Wide-field contact fundus photograph of an infant.
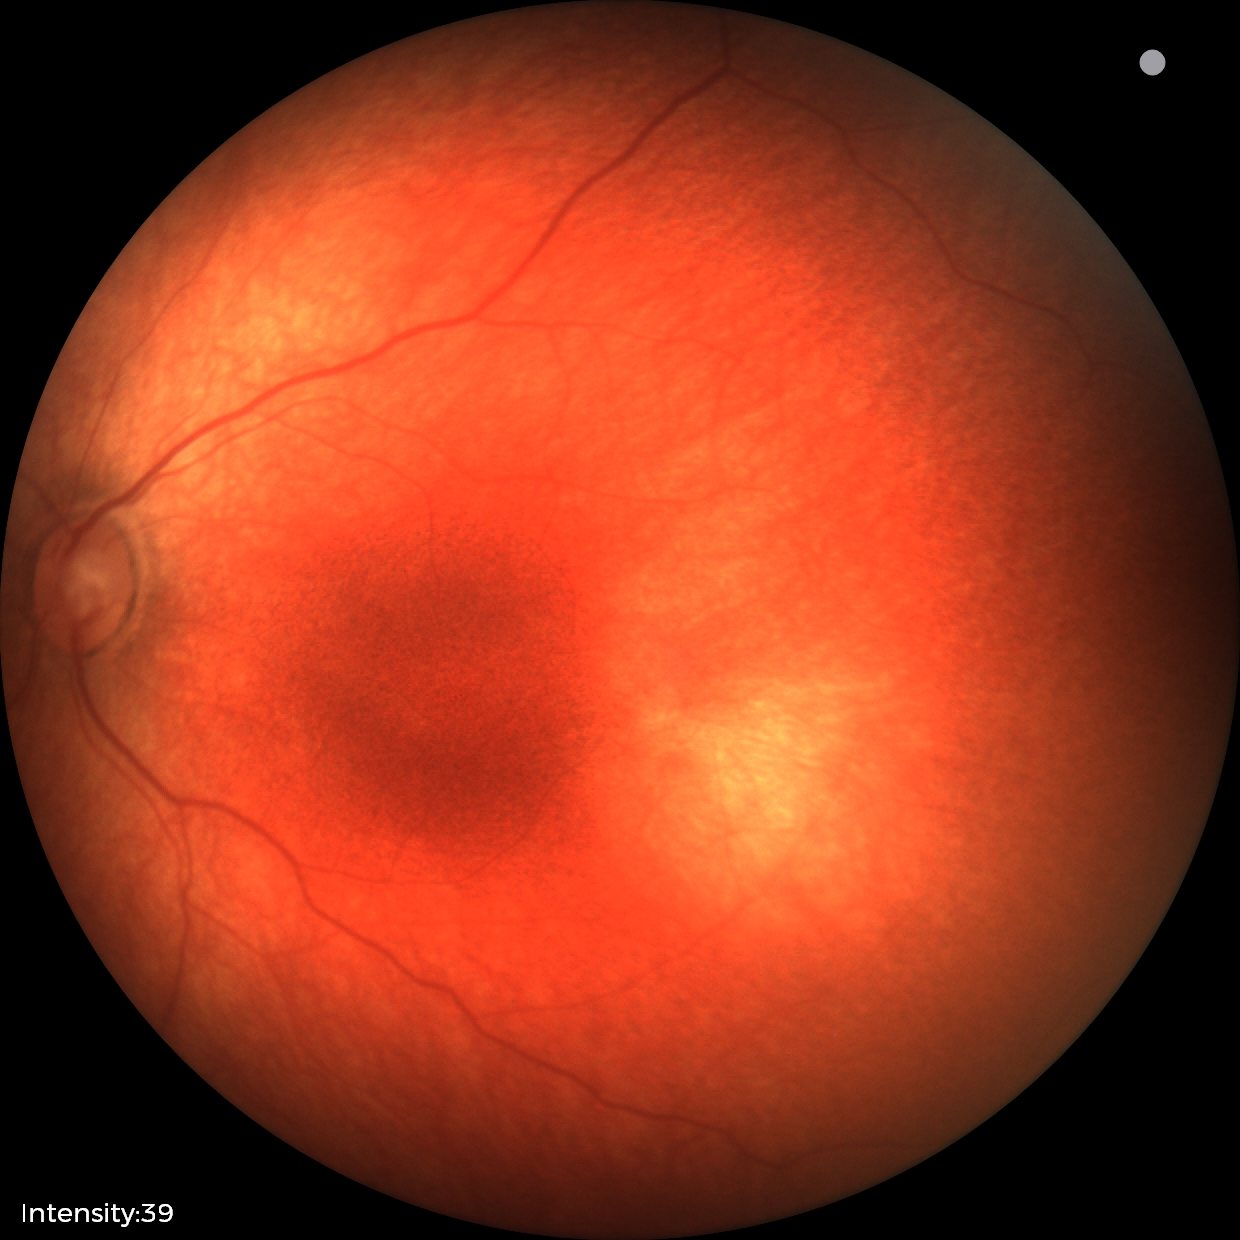
Normal screening examination.